Gender: F. 30-degree field of view.
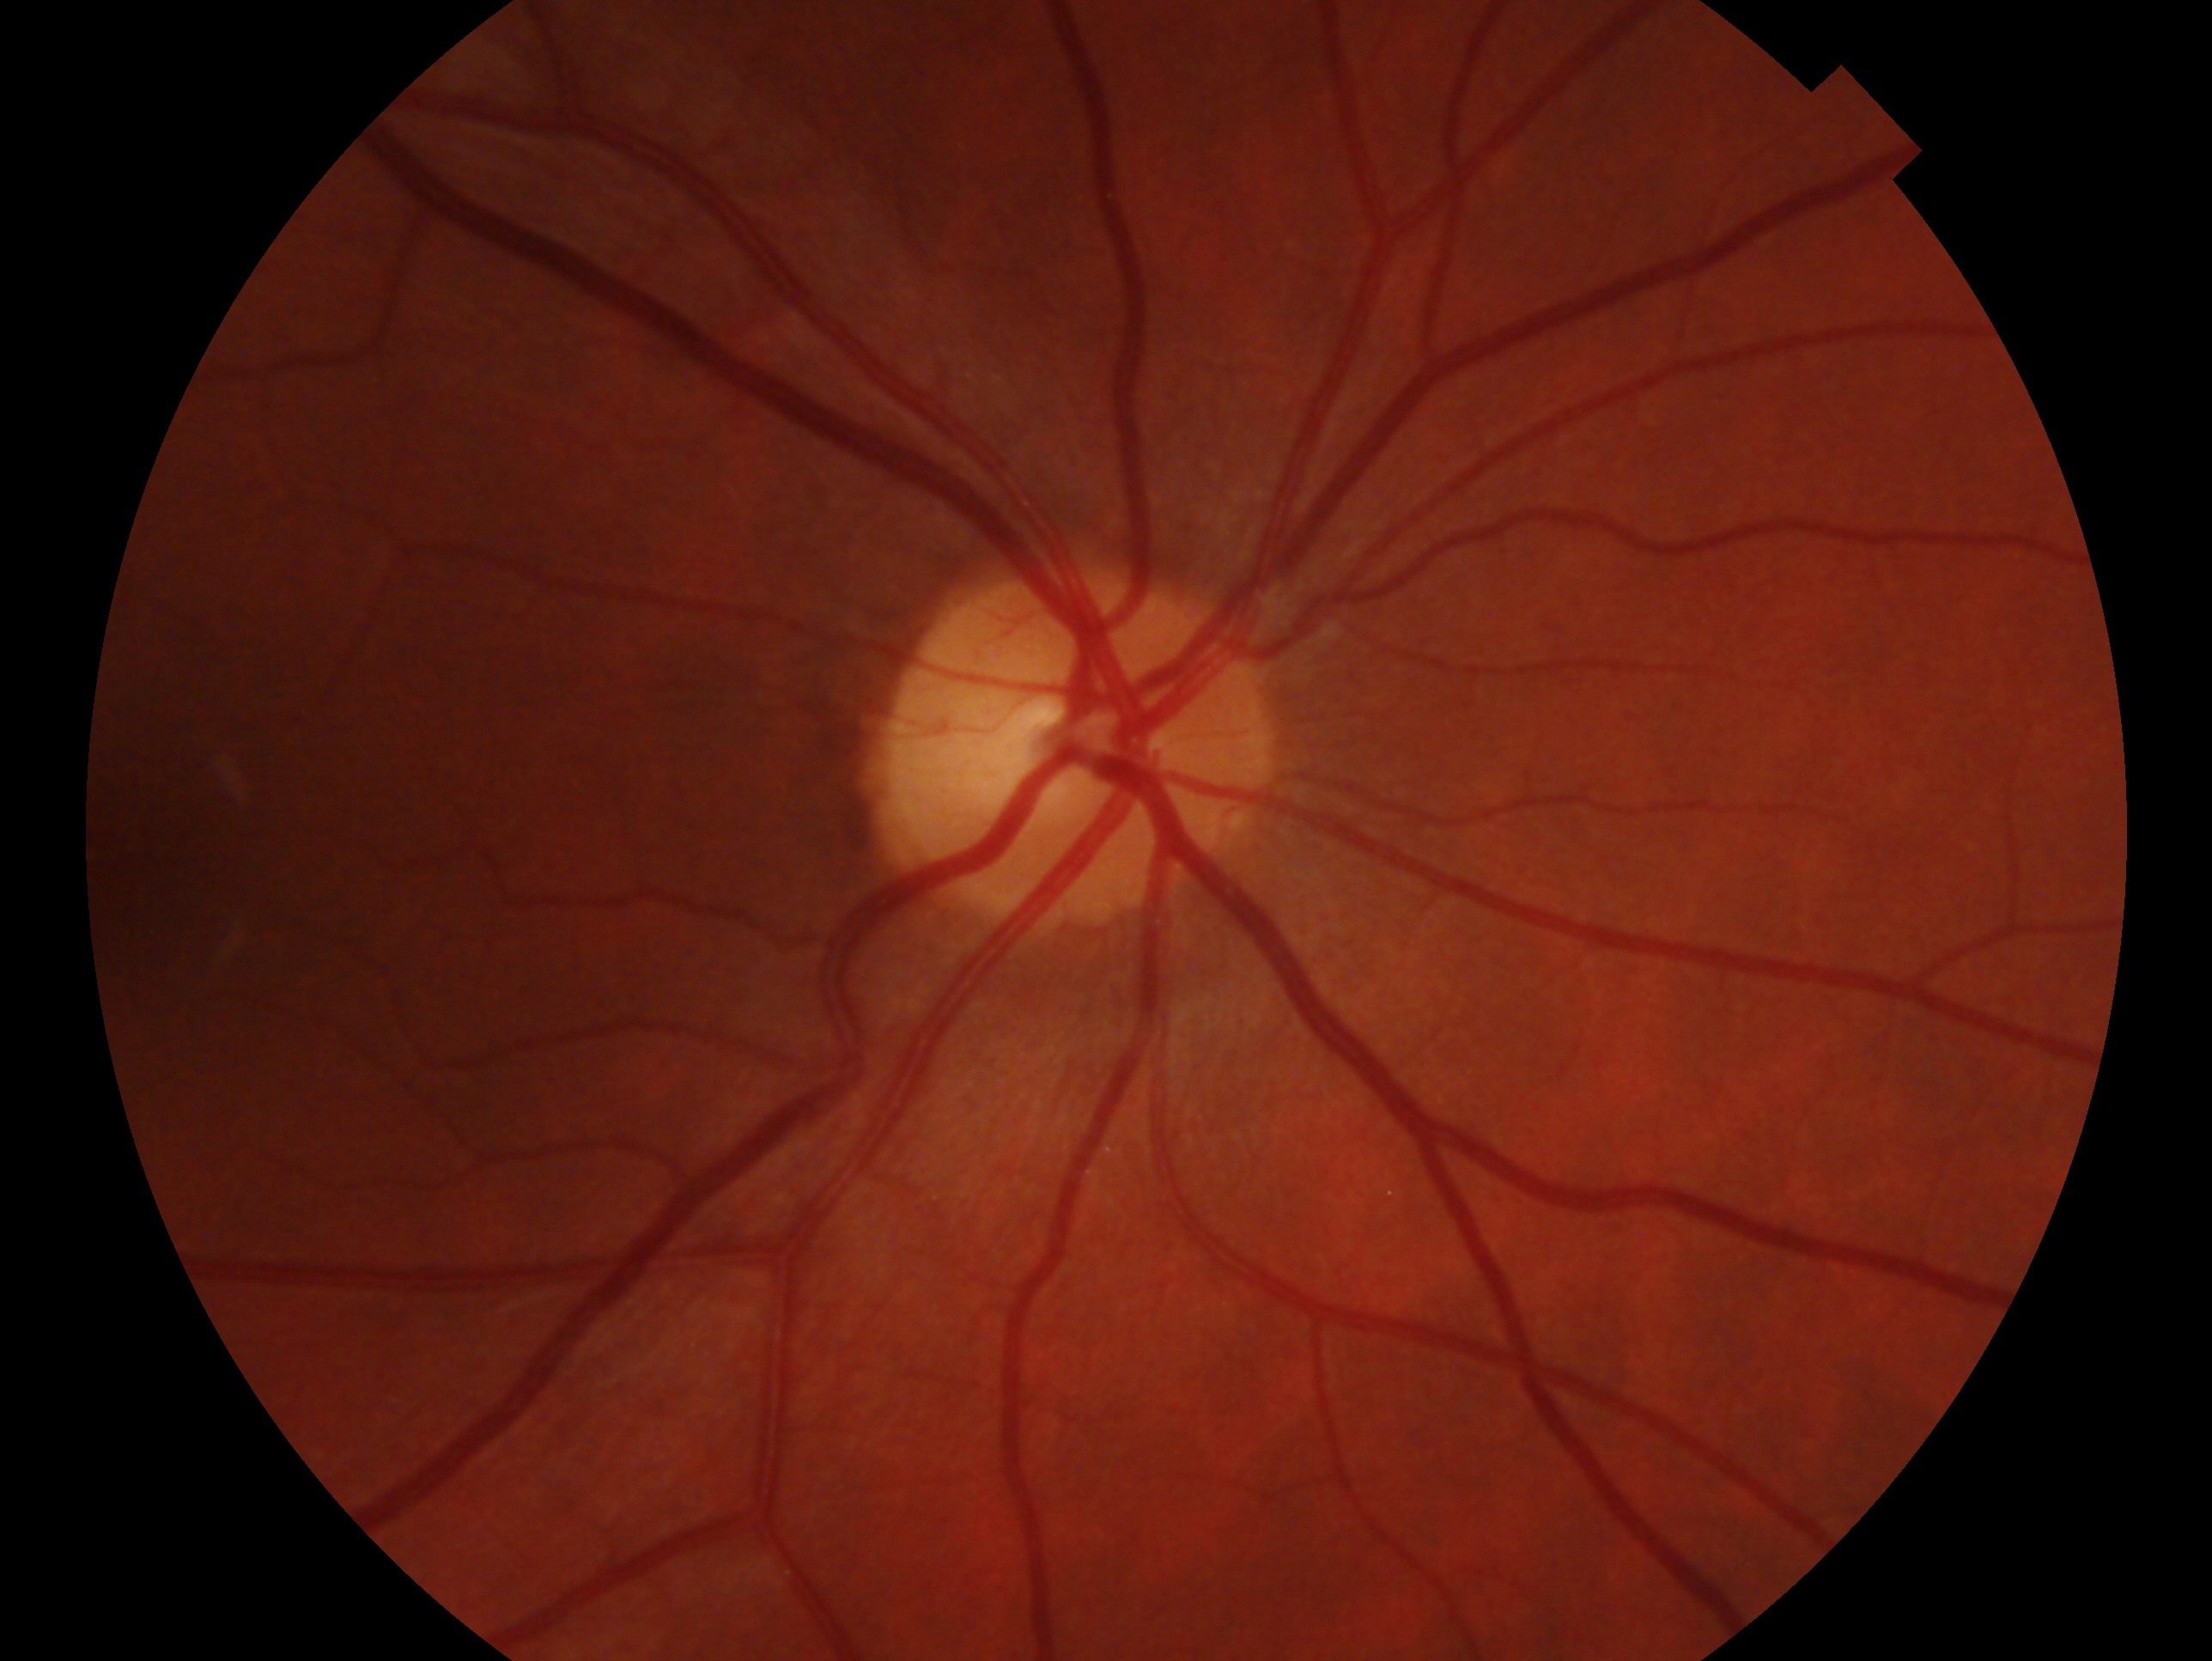 diagnosis: no evidence of glaucoma, laterality: right.